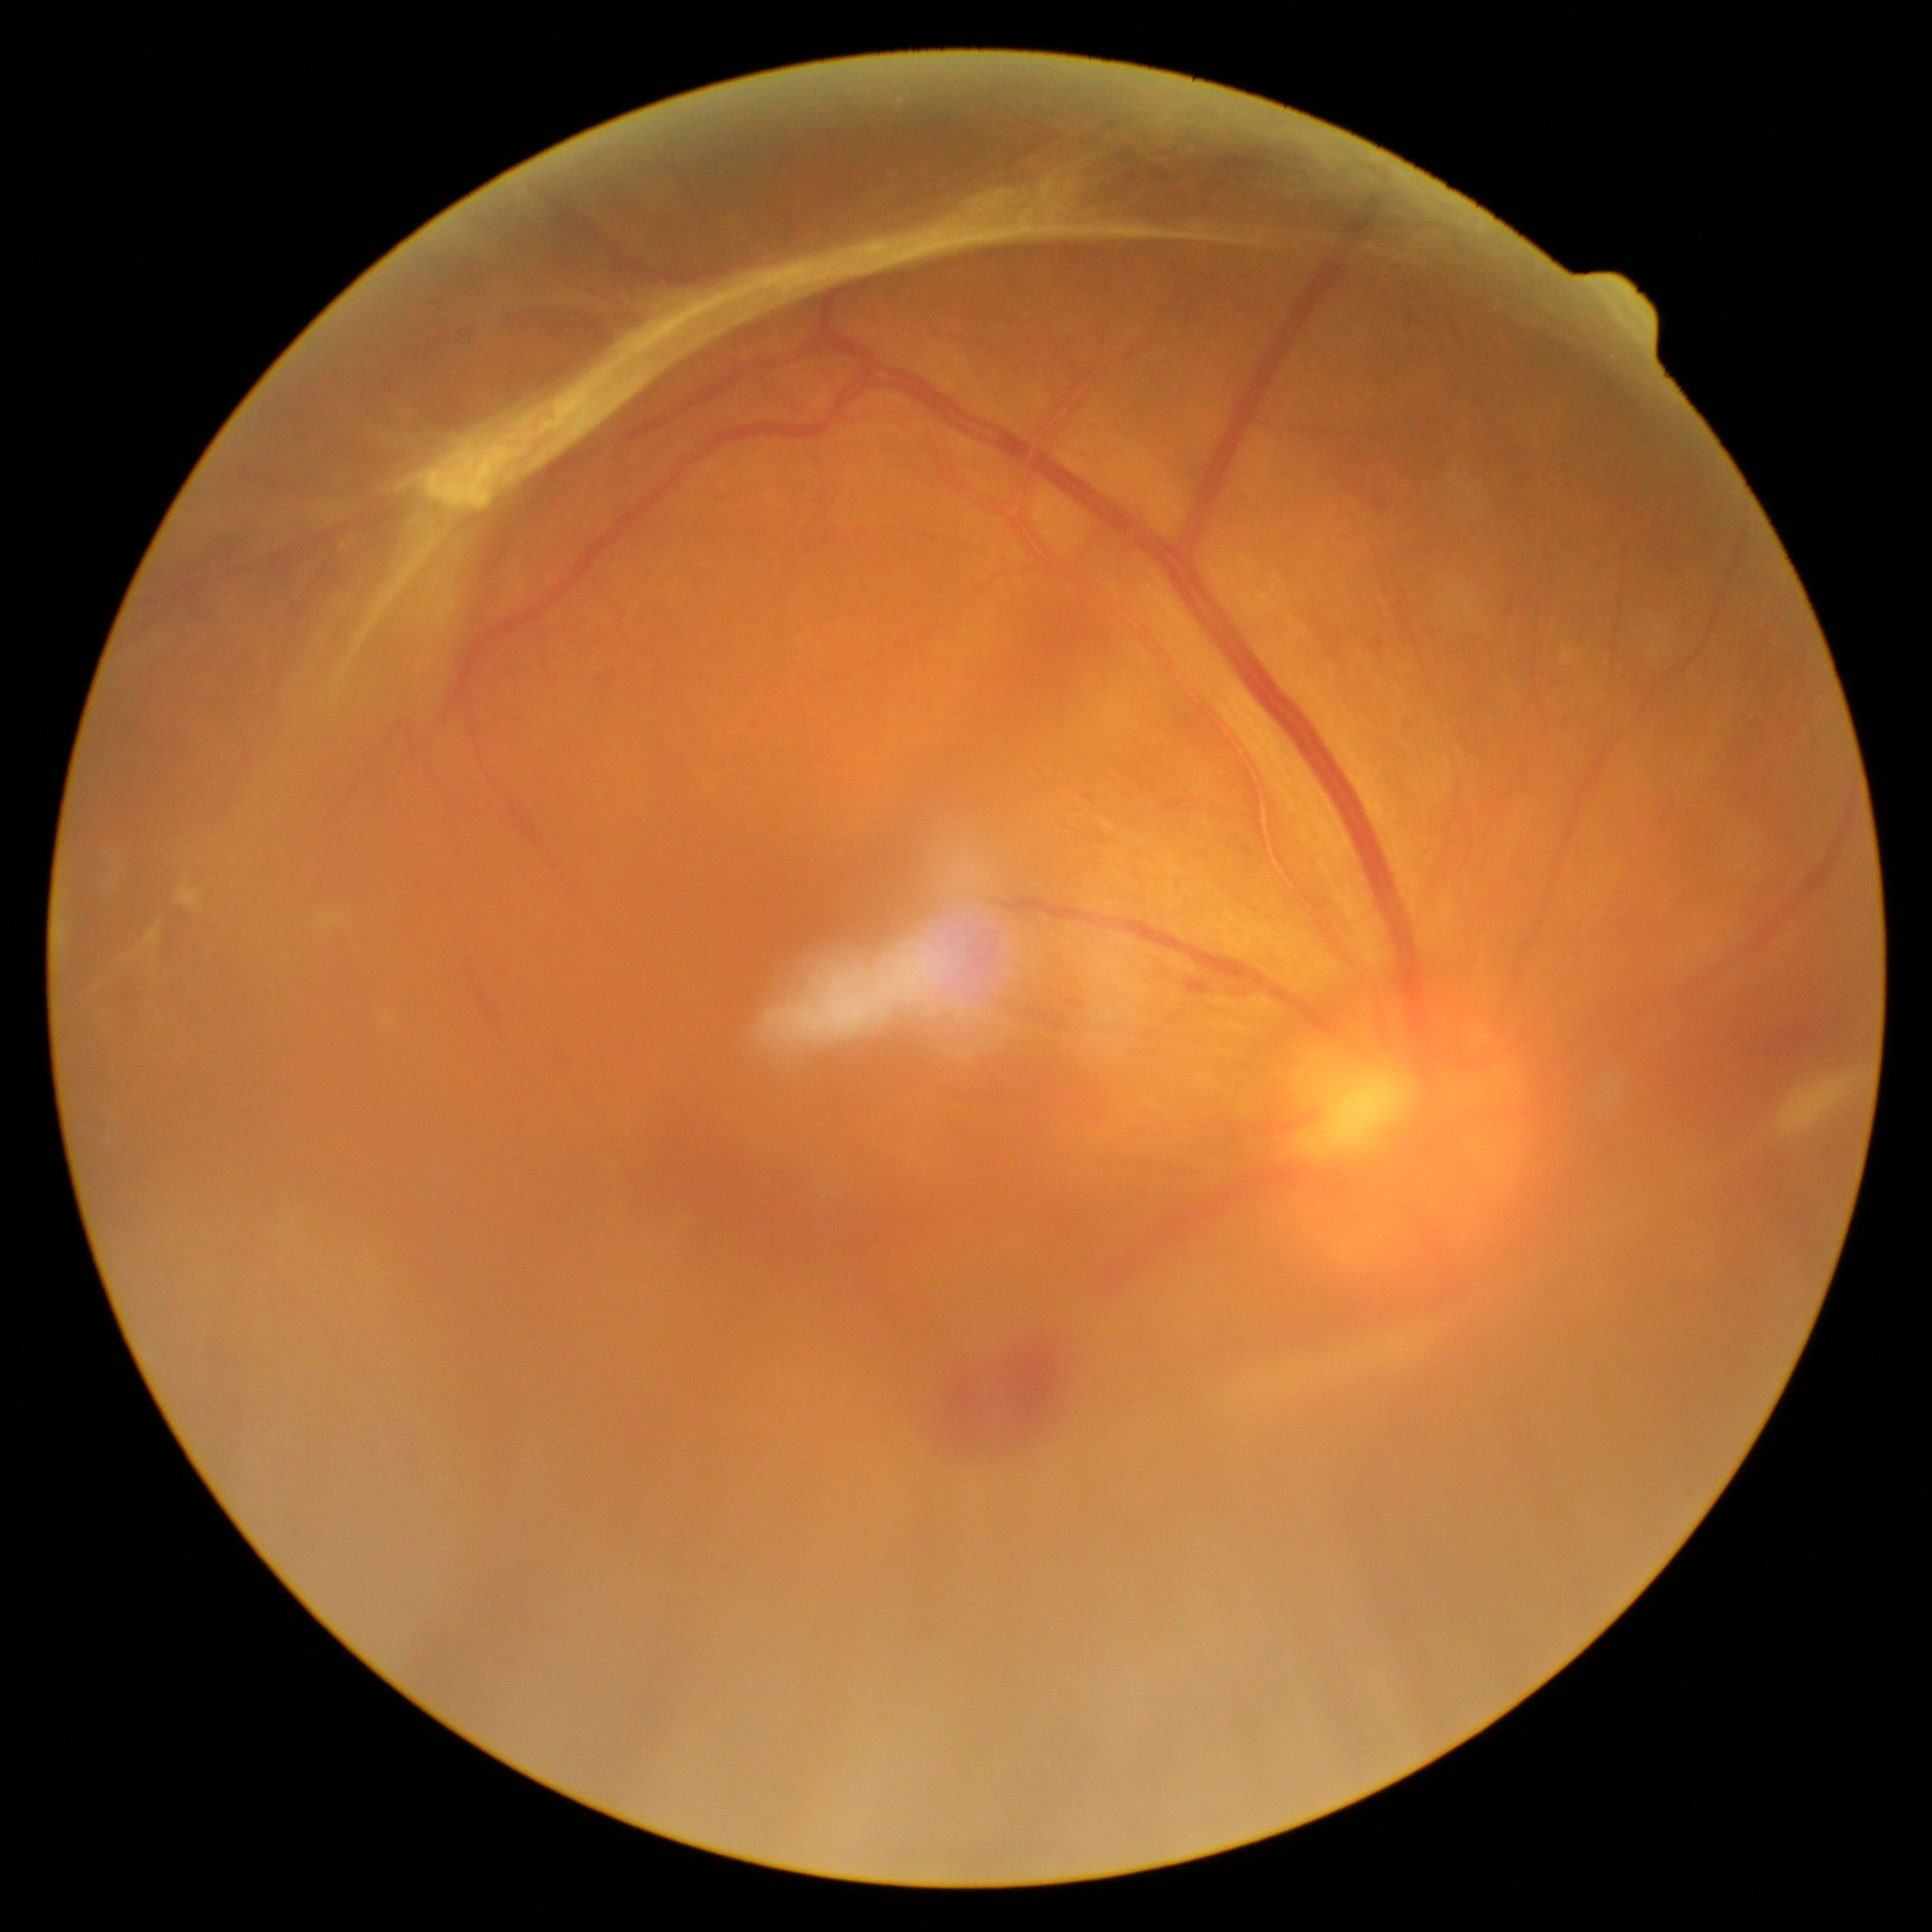 DR severity: grade 4.